Wide-field retinal mosaic image · 200-degree field of view.
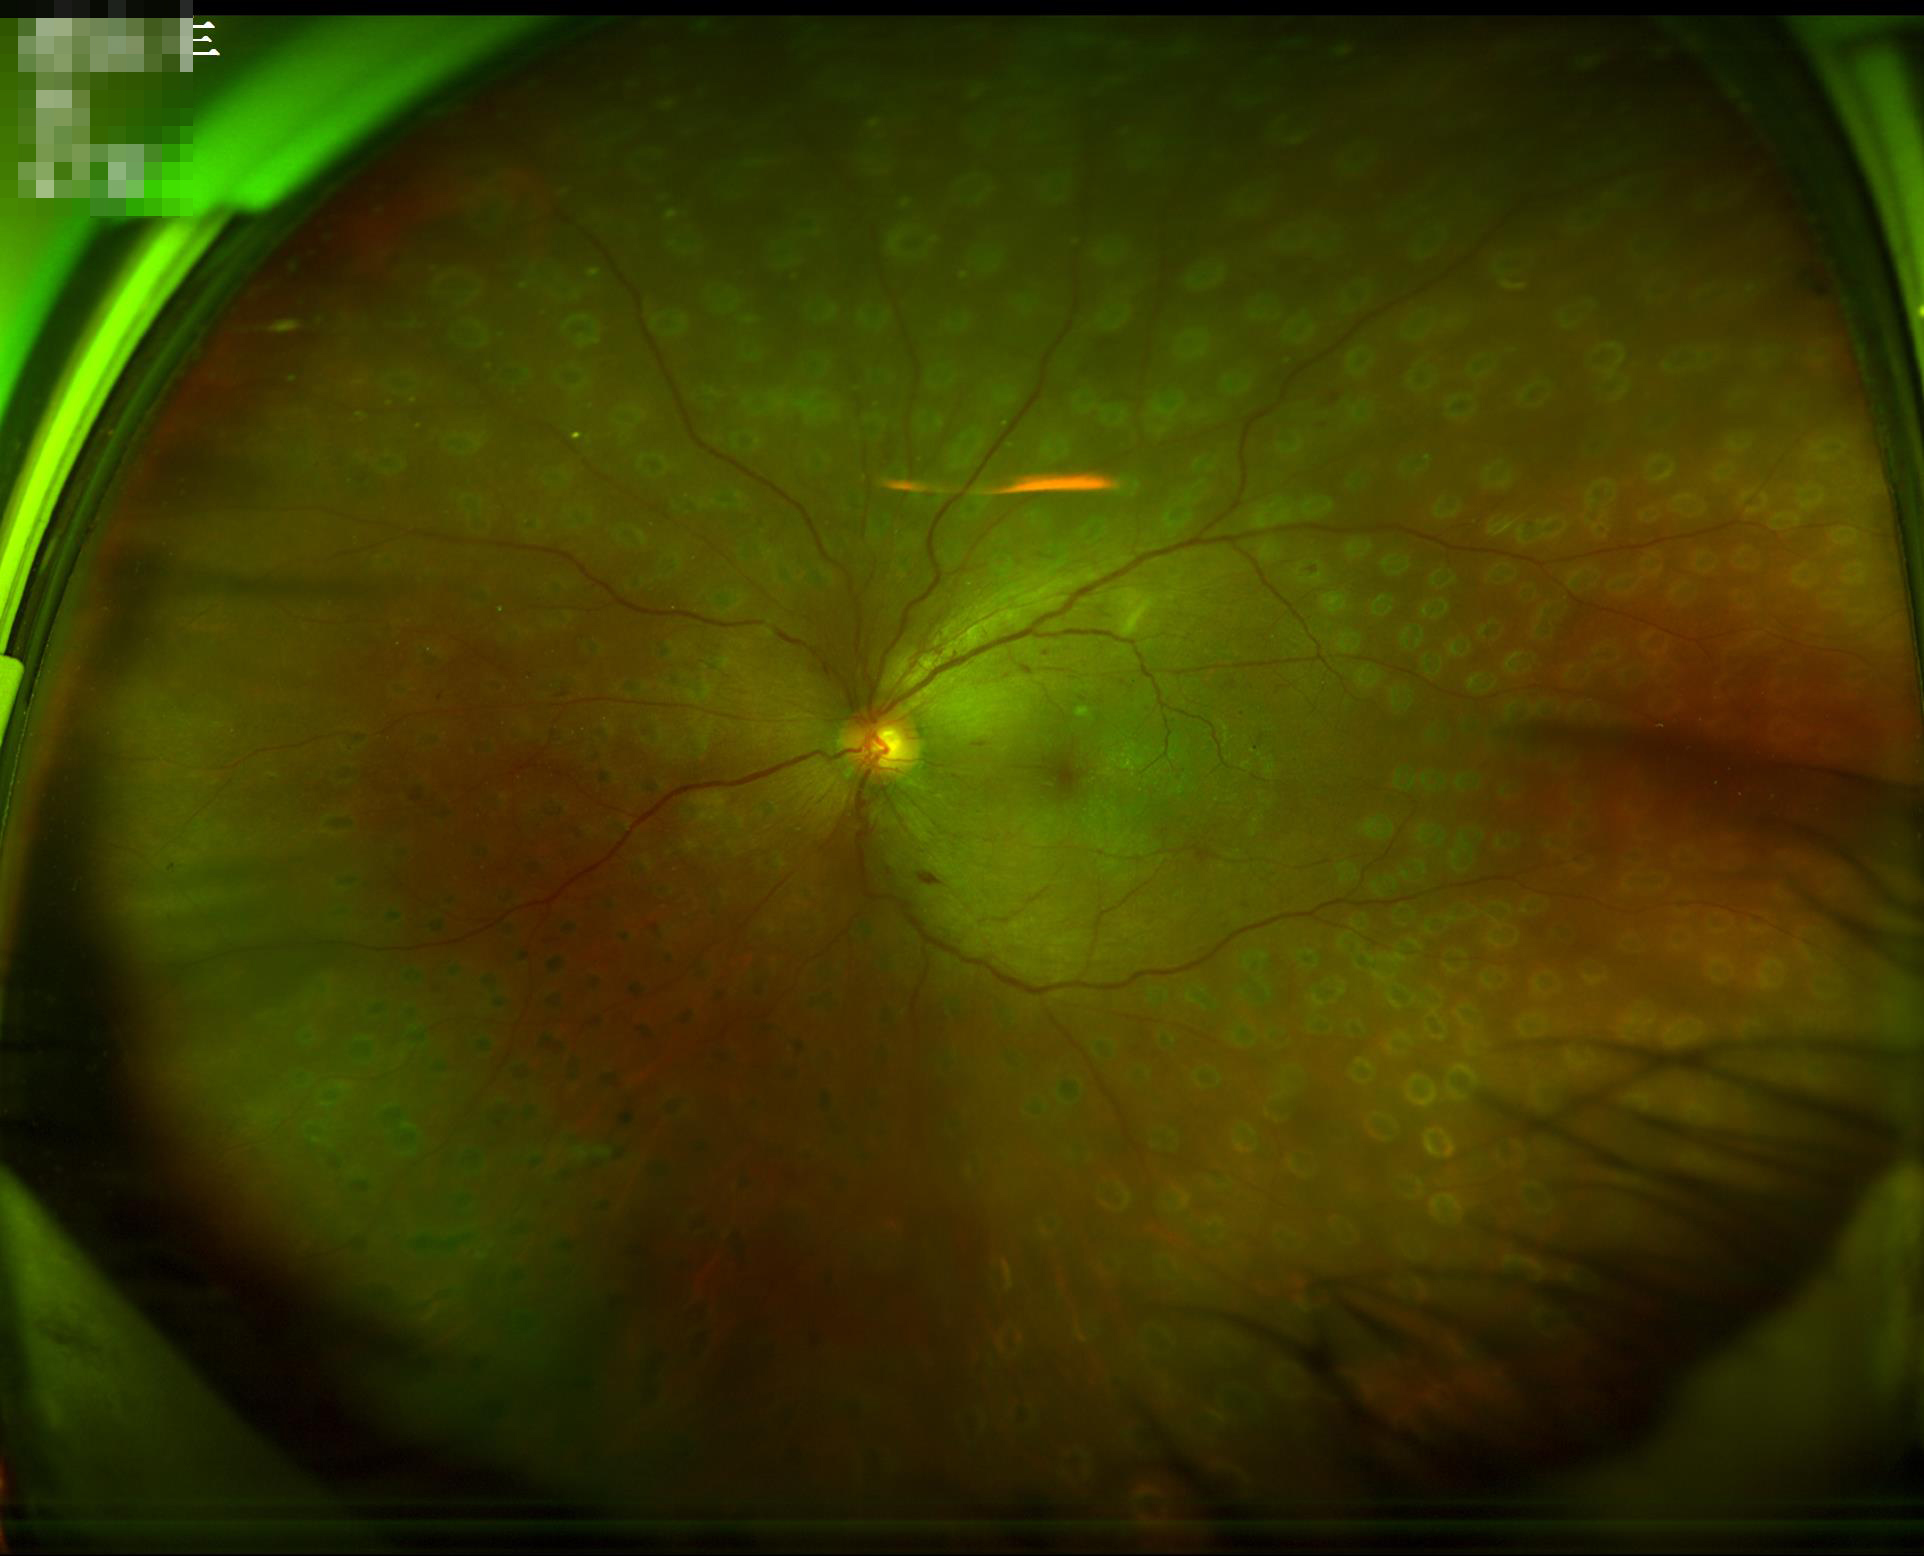 {
  "clarity": "in focus",
  "illumination": "even",
  "contrast": "satisfactory"
}